Topcon TRC-NW8.
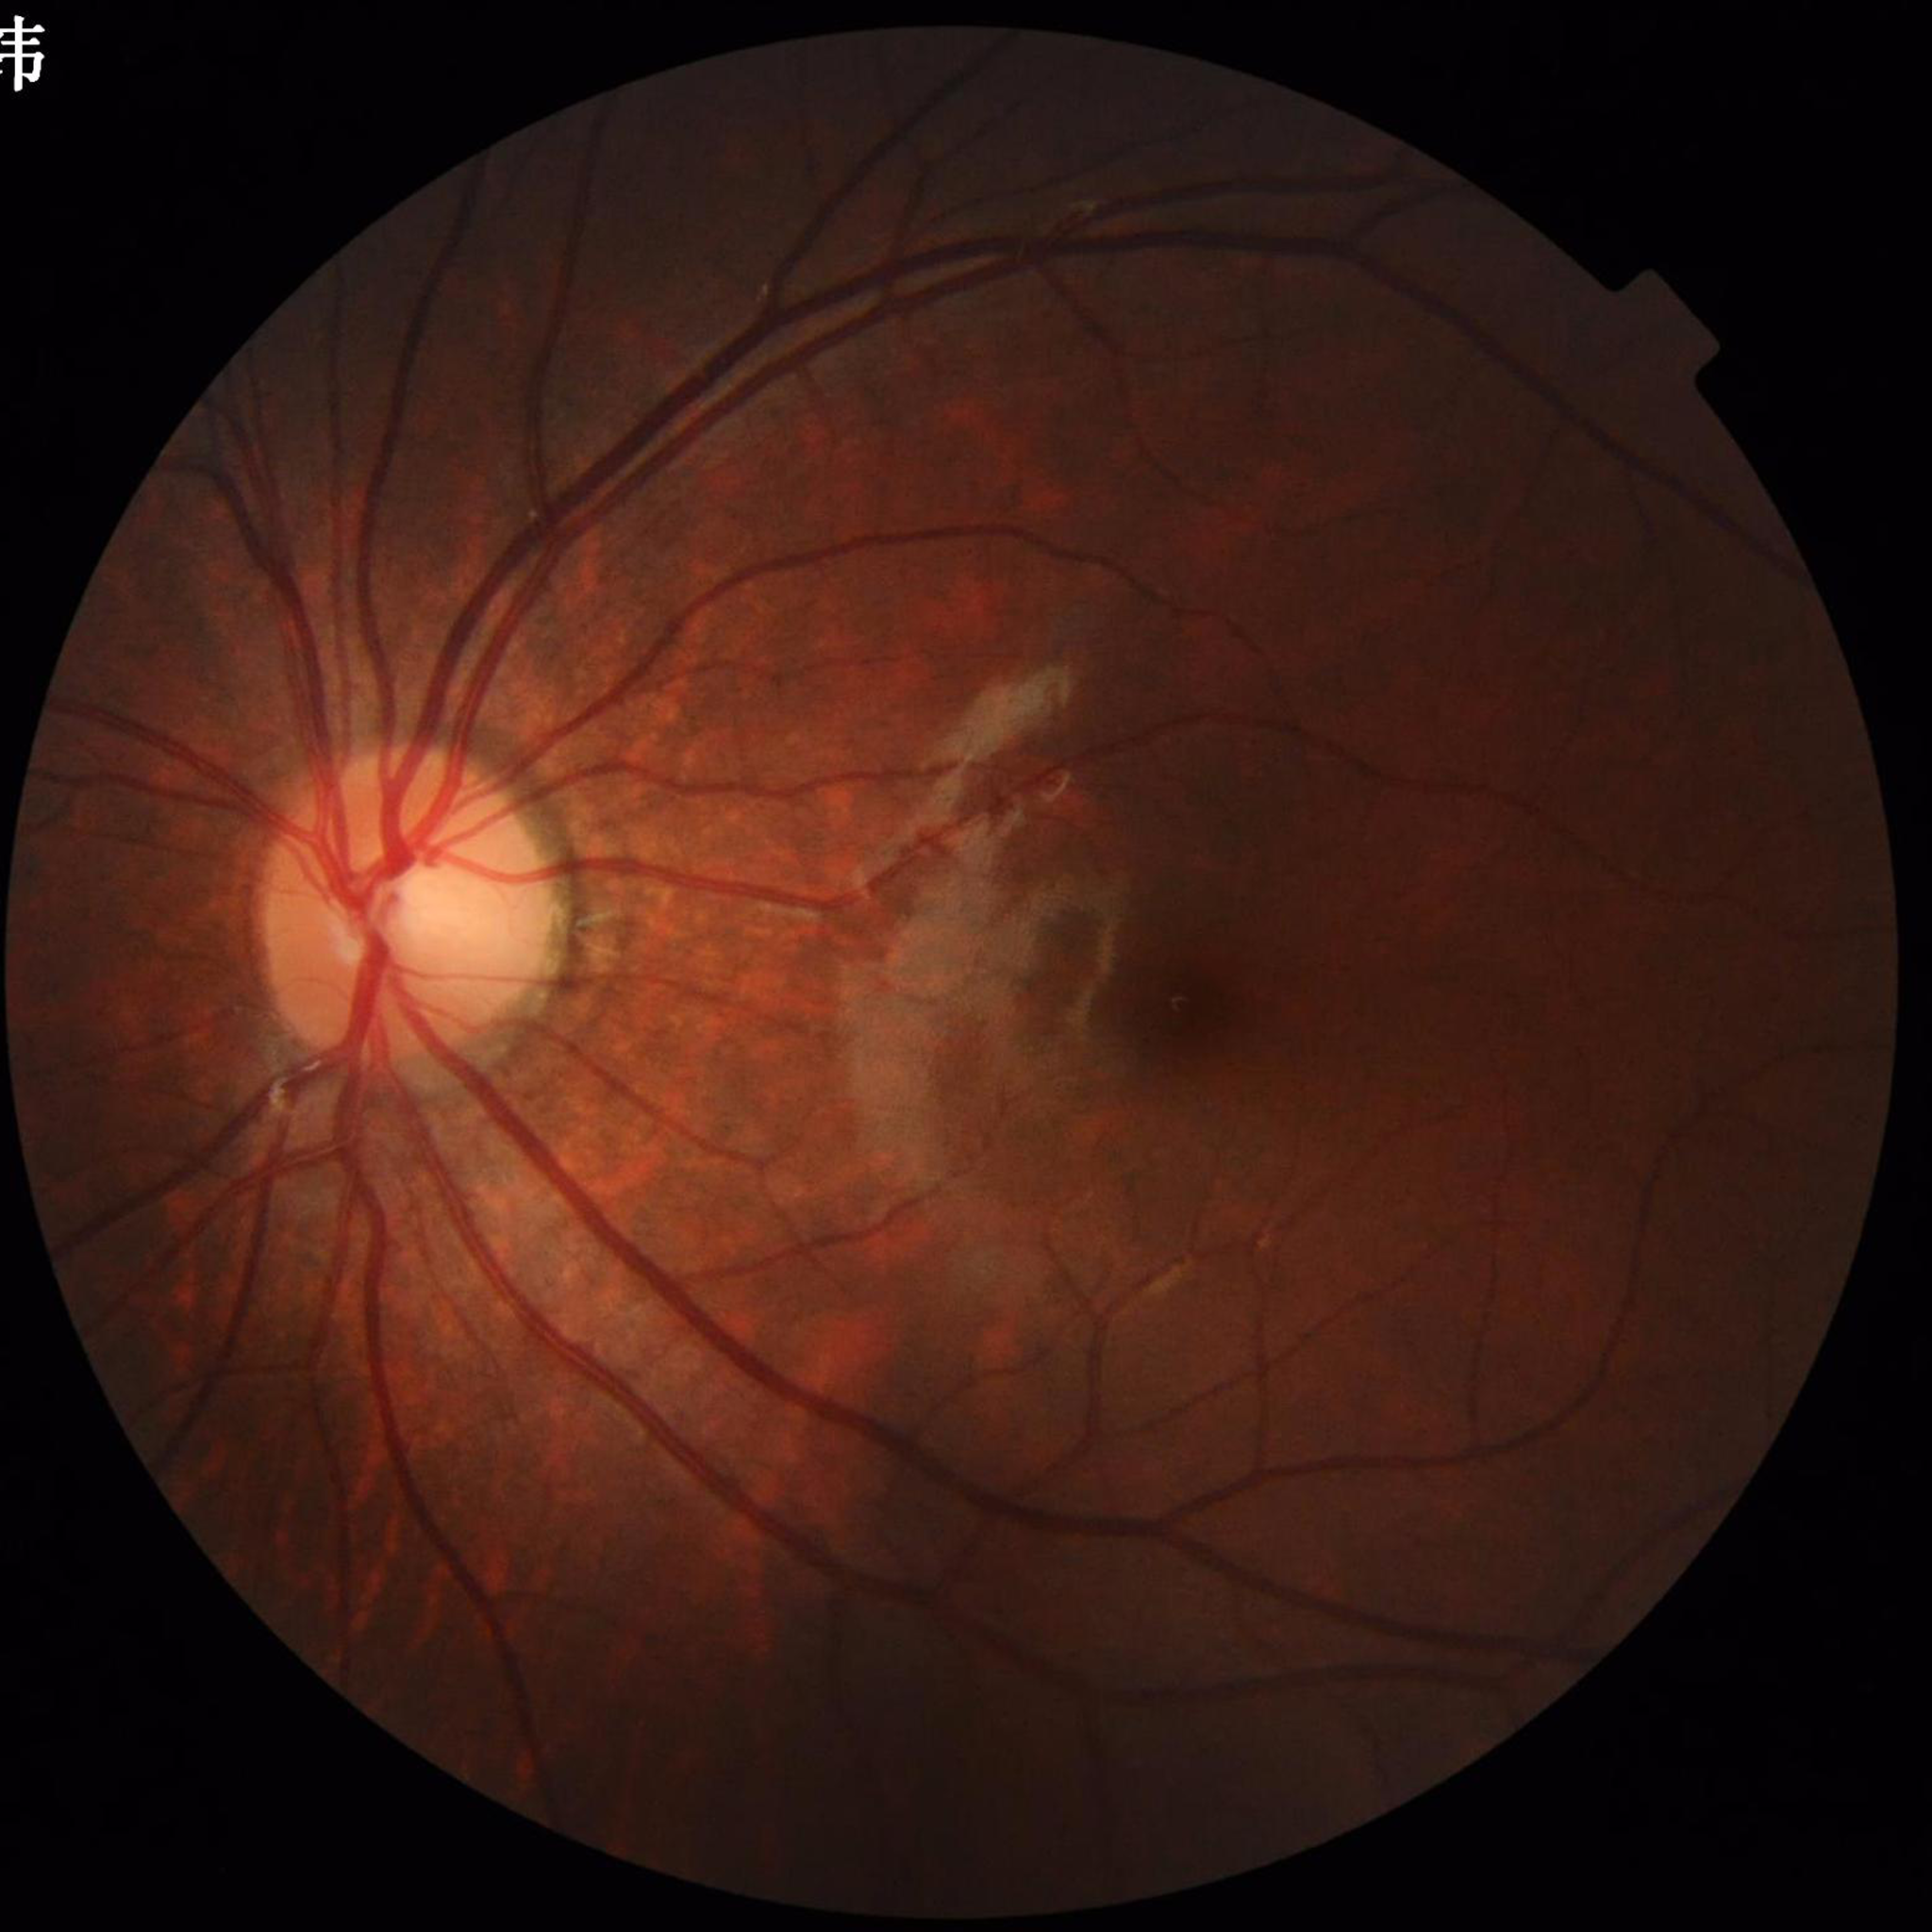
{
  "diagnosis": "no AMD, diabetic retinopathy, or glaucoma",
  "image_quality": "contrast adequate, no blur, illumination/color distortion present"
}